No pharmacologic dilation.
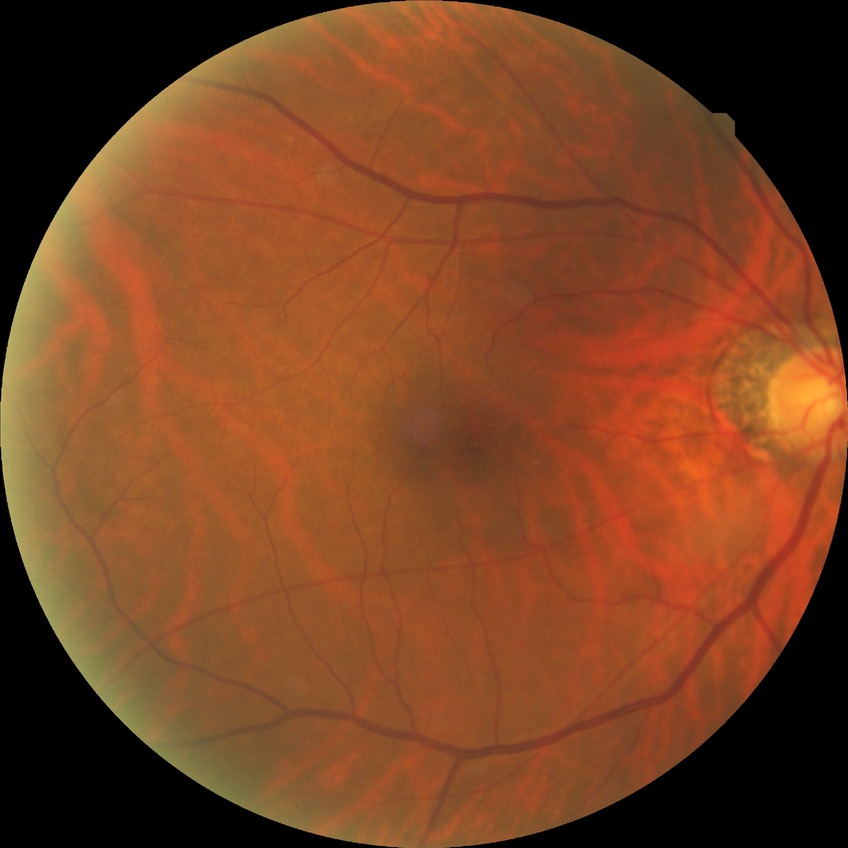

diabetic retinopathy stage = no diabetic retinopathy.